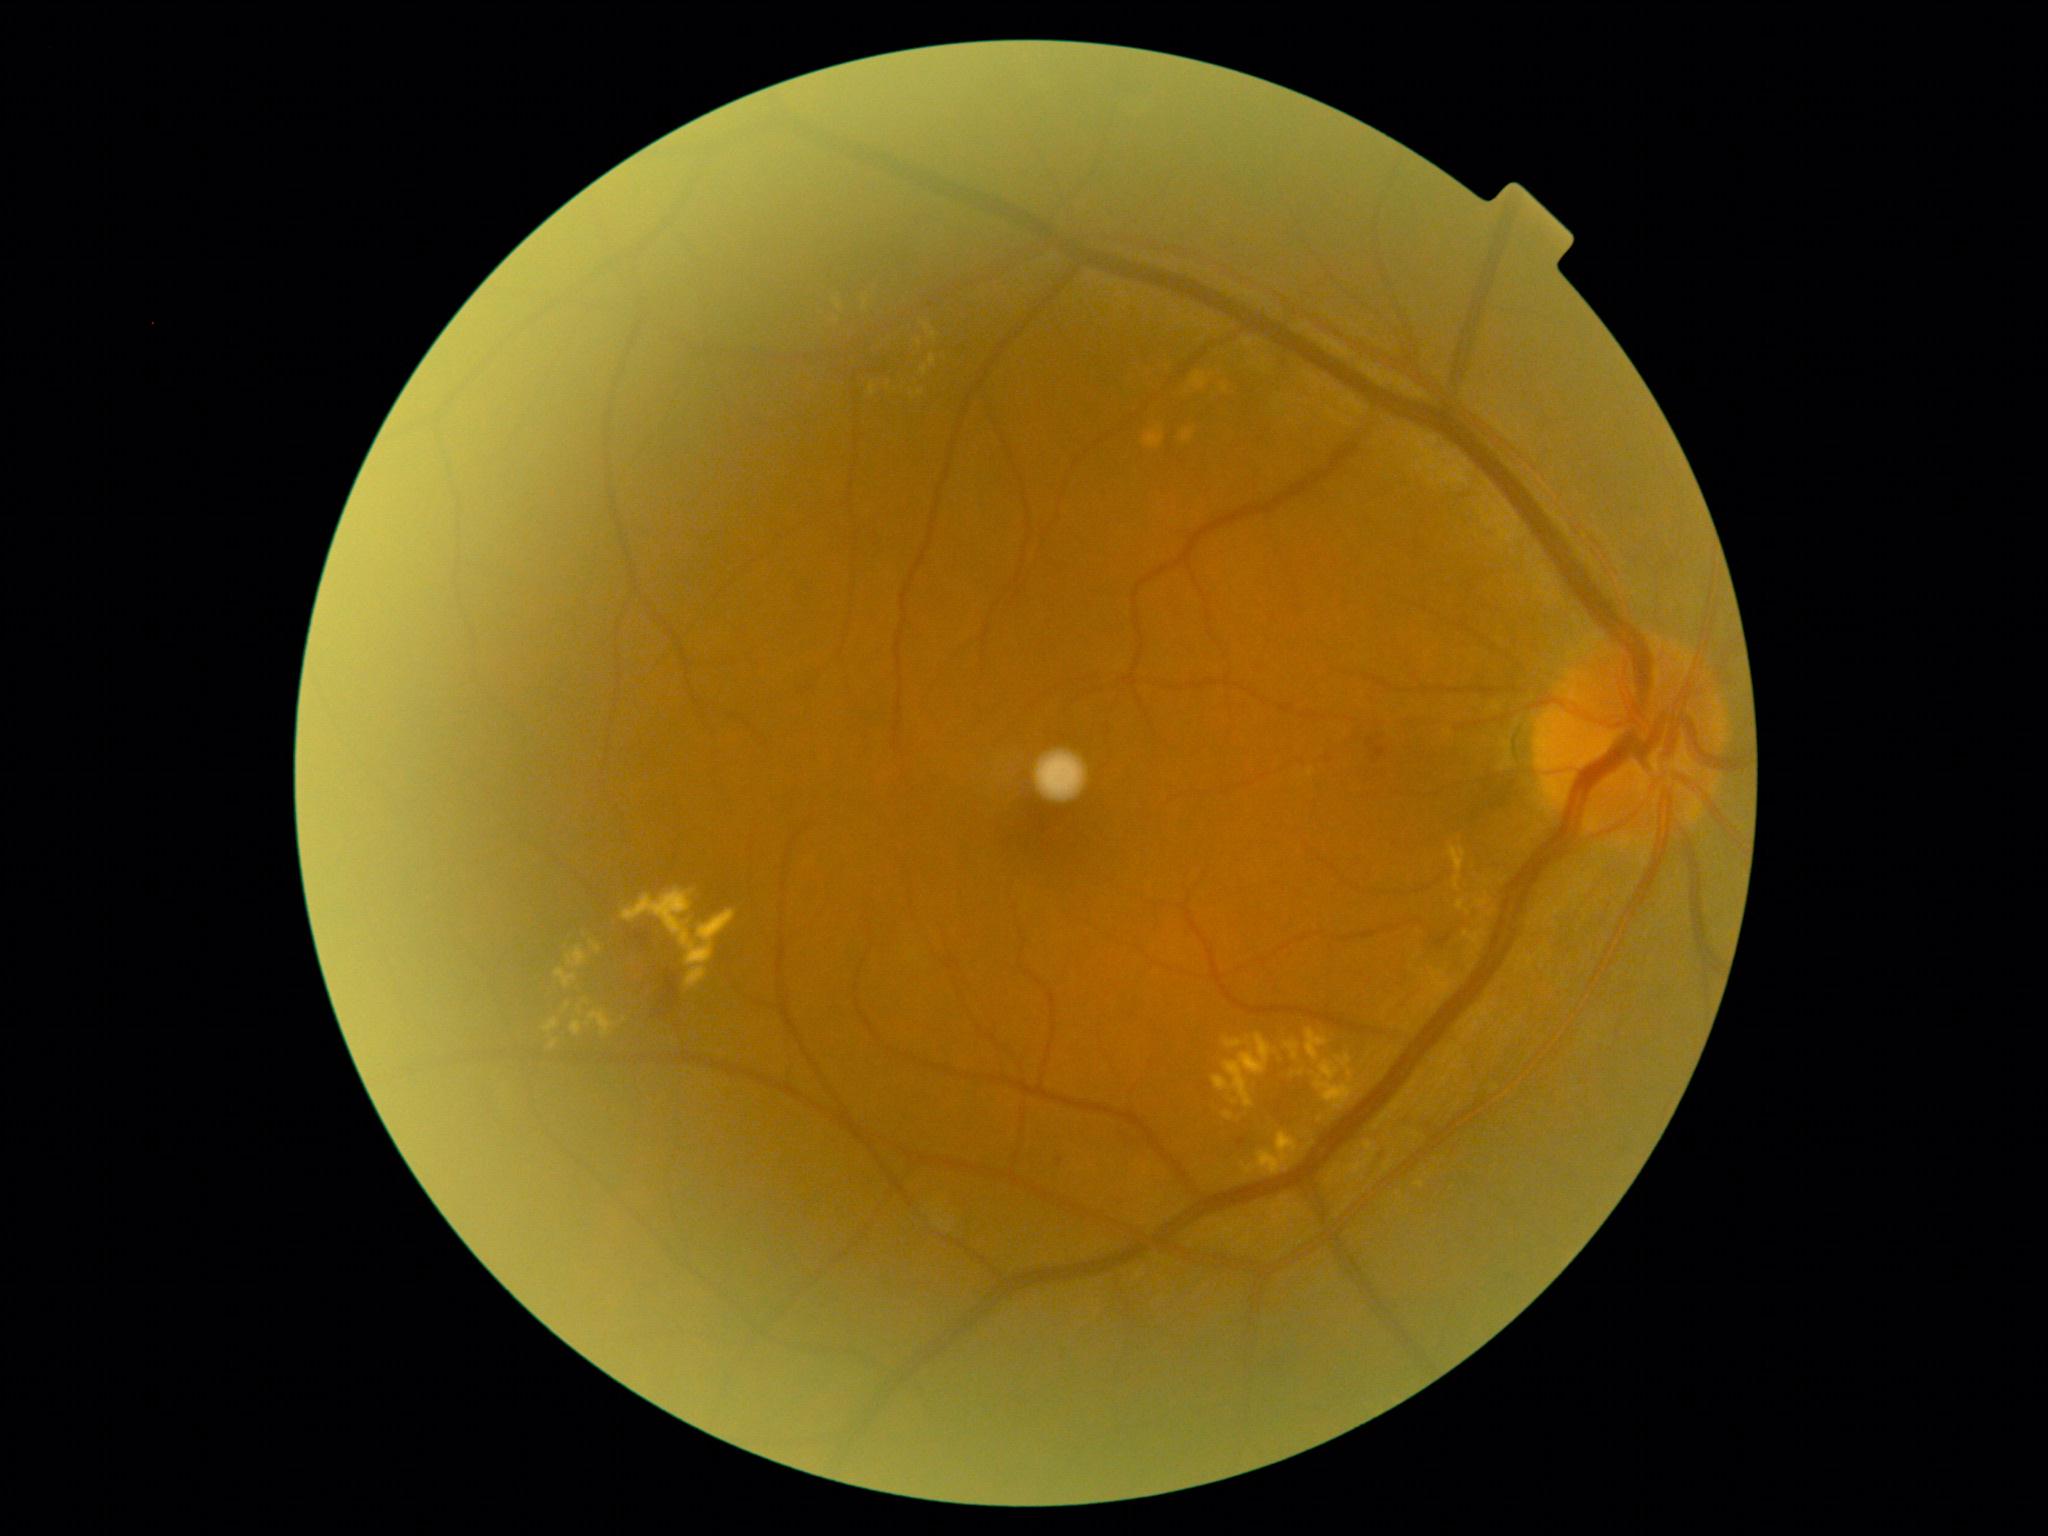 Diabetic retinopathy severity is 2/4
A subset of detected lesions:
• hemorrhages: <box>660,968,680,1008</box>
• hard exudates (partial): <box>686,967,707,988</box> | <box>623,888,737,965</box> | <box>590,940,603,954</box> | <box>1457,900,1472,915</box> | <box>1306,1028,1329,1061</box> | <box>1224,1038,1251,1048</box> | <box>920,365,929,376</box> | <box>1448,845,1467,891</box> | <box>1224,1111,1234,1120</box> | <box>870,384,876,396</box> | <box>916,391,924,396</box> | <box>1242,1131,1298,1176</box> | <box>551,1040,558,1048</box>
• Smaller hard exudates around (927,328) | (1220,1173) | (865,303) | (1302,1072) | (1312,1144)
• microaneurysms: <box>1058,1157,1063,1167</box> | <box>1236,1138,1246,1147</box> | <box>1372,747,1387,762</box>
• soft exudates: none identified